Camera: NIDEK AFC-230; 848 by 848 pixels — 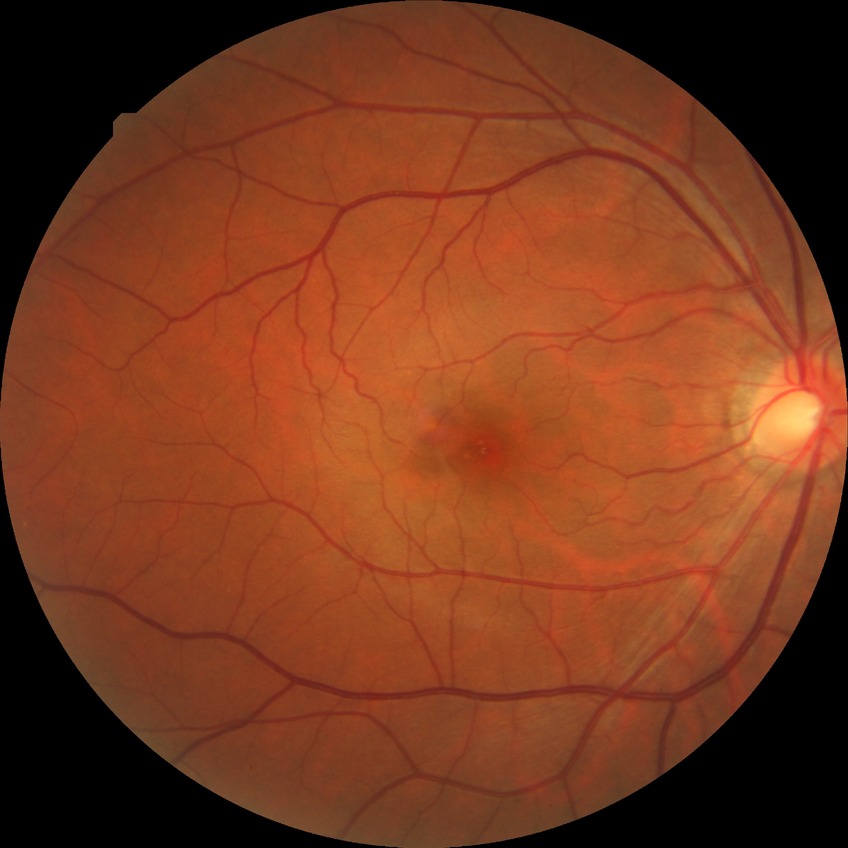

modified Davis grade=NDR.